1240 x 1240 pixels; 100° field of view (Phoenix ICON); infant wide-field fundus photograph:
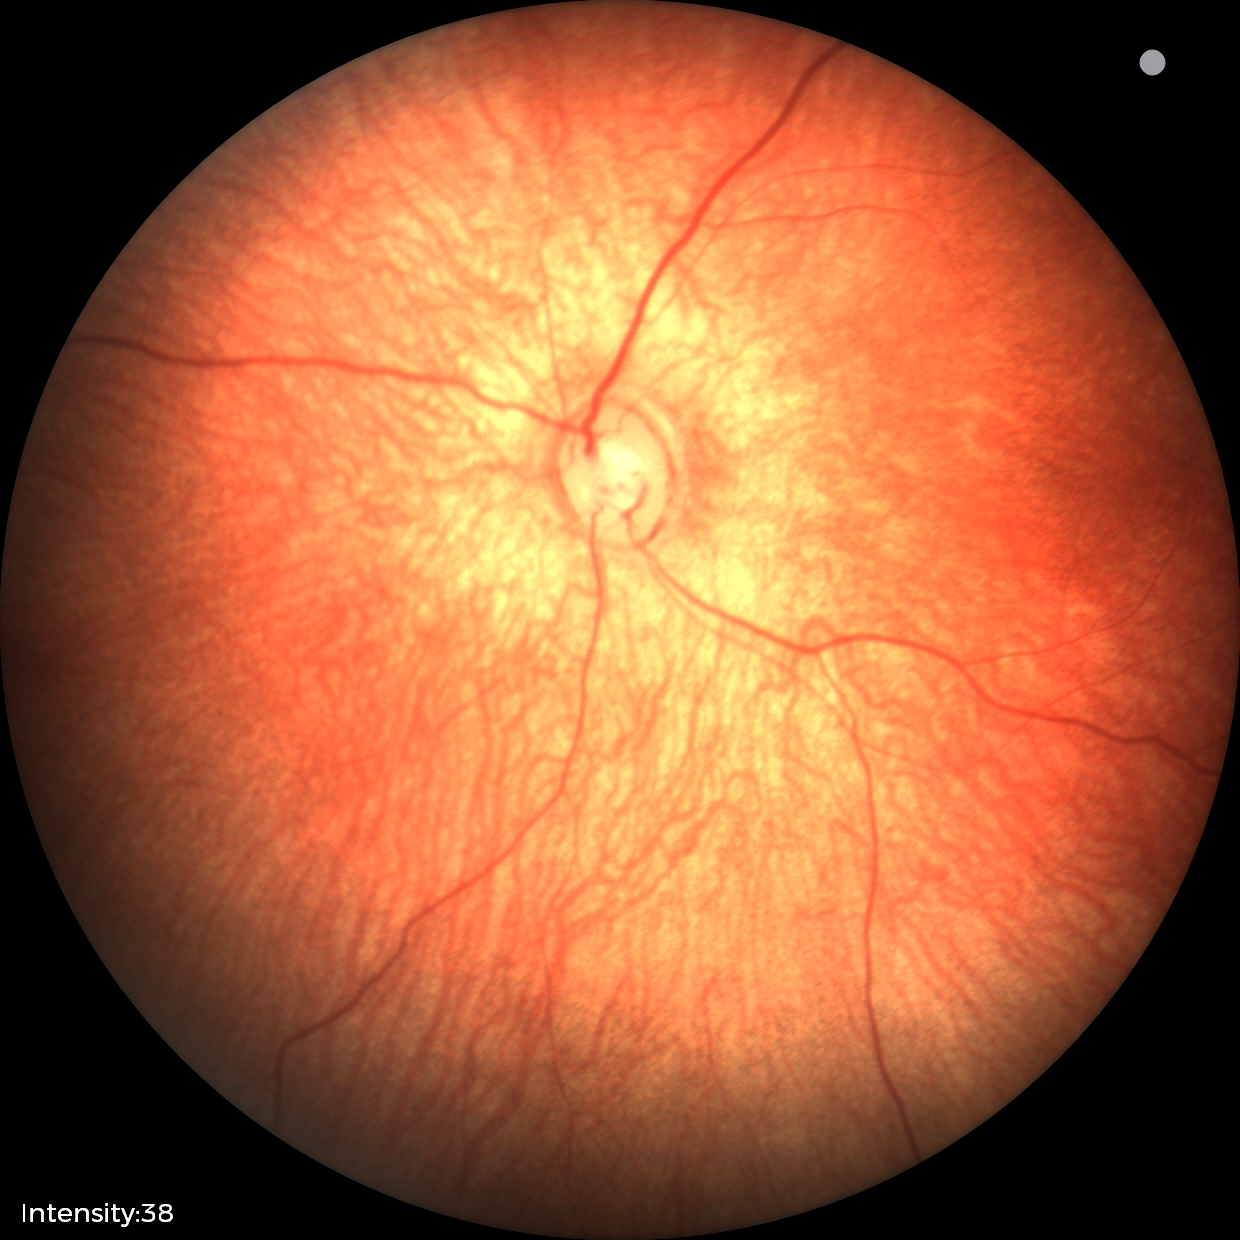 Impression: physiological.